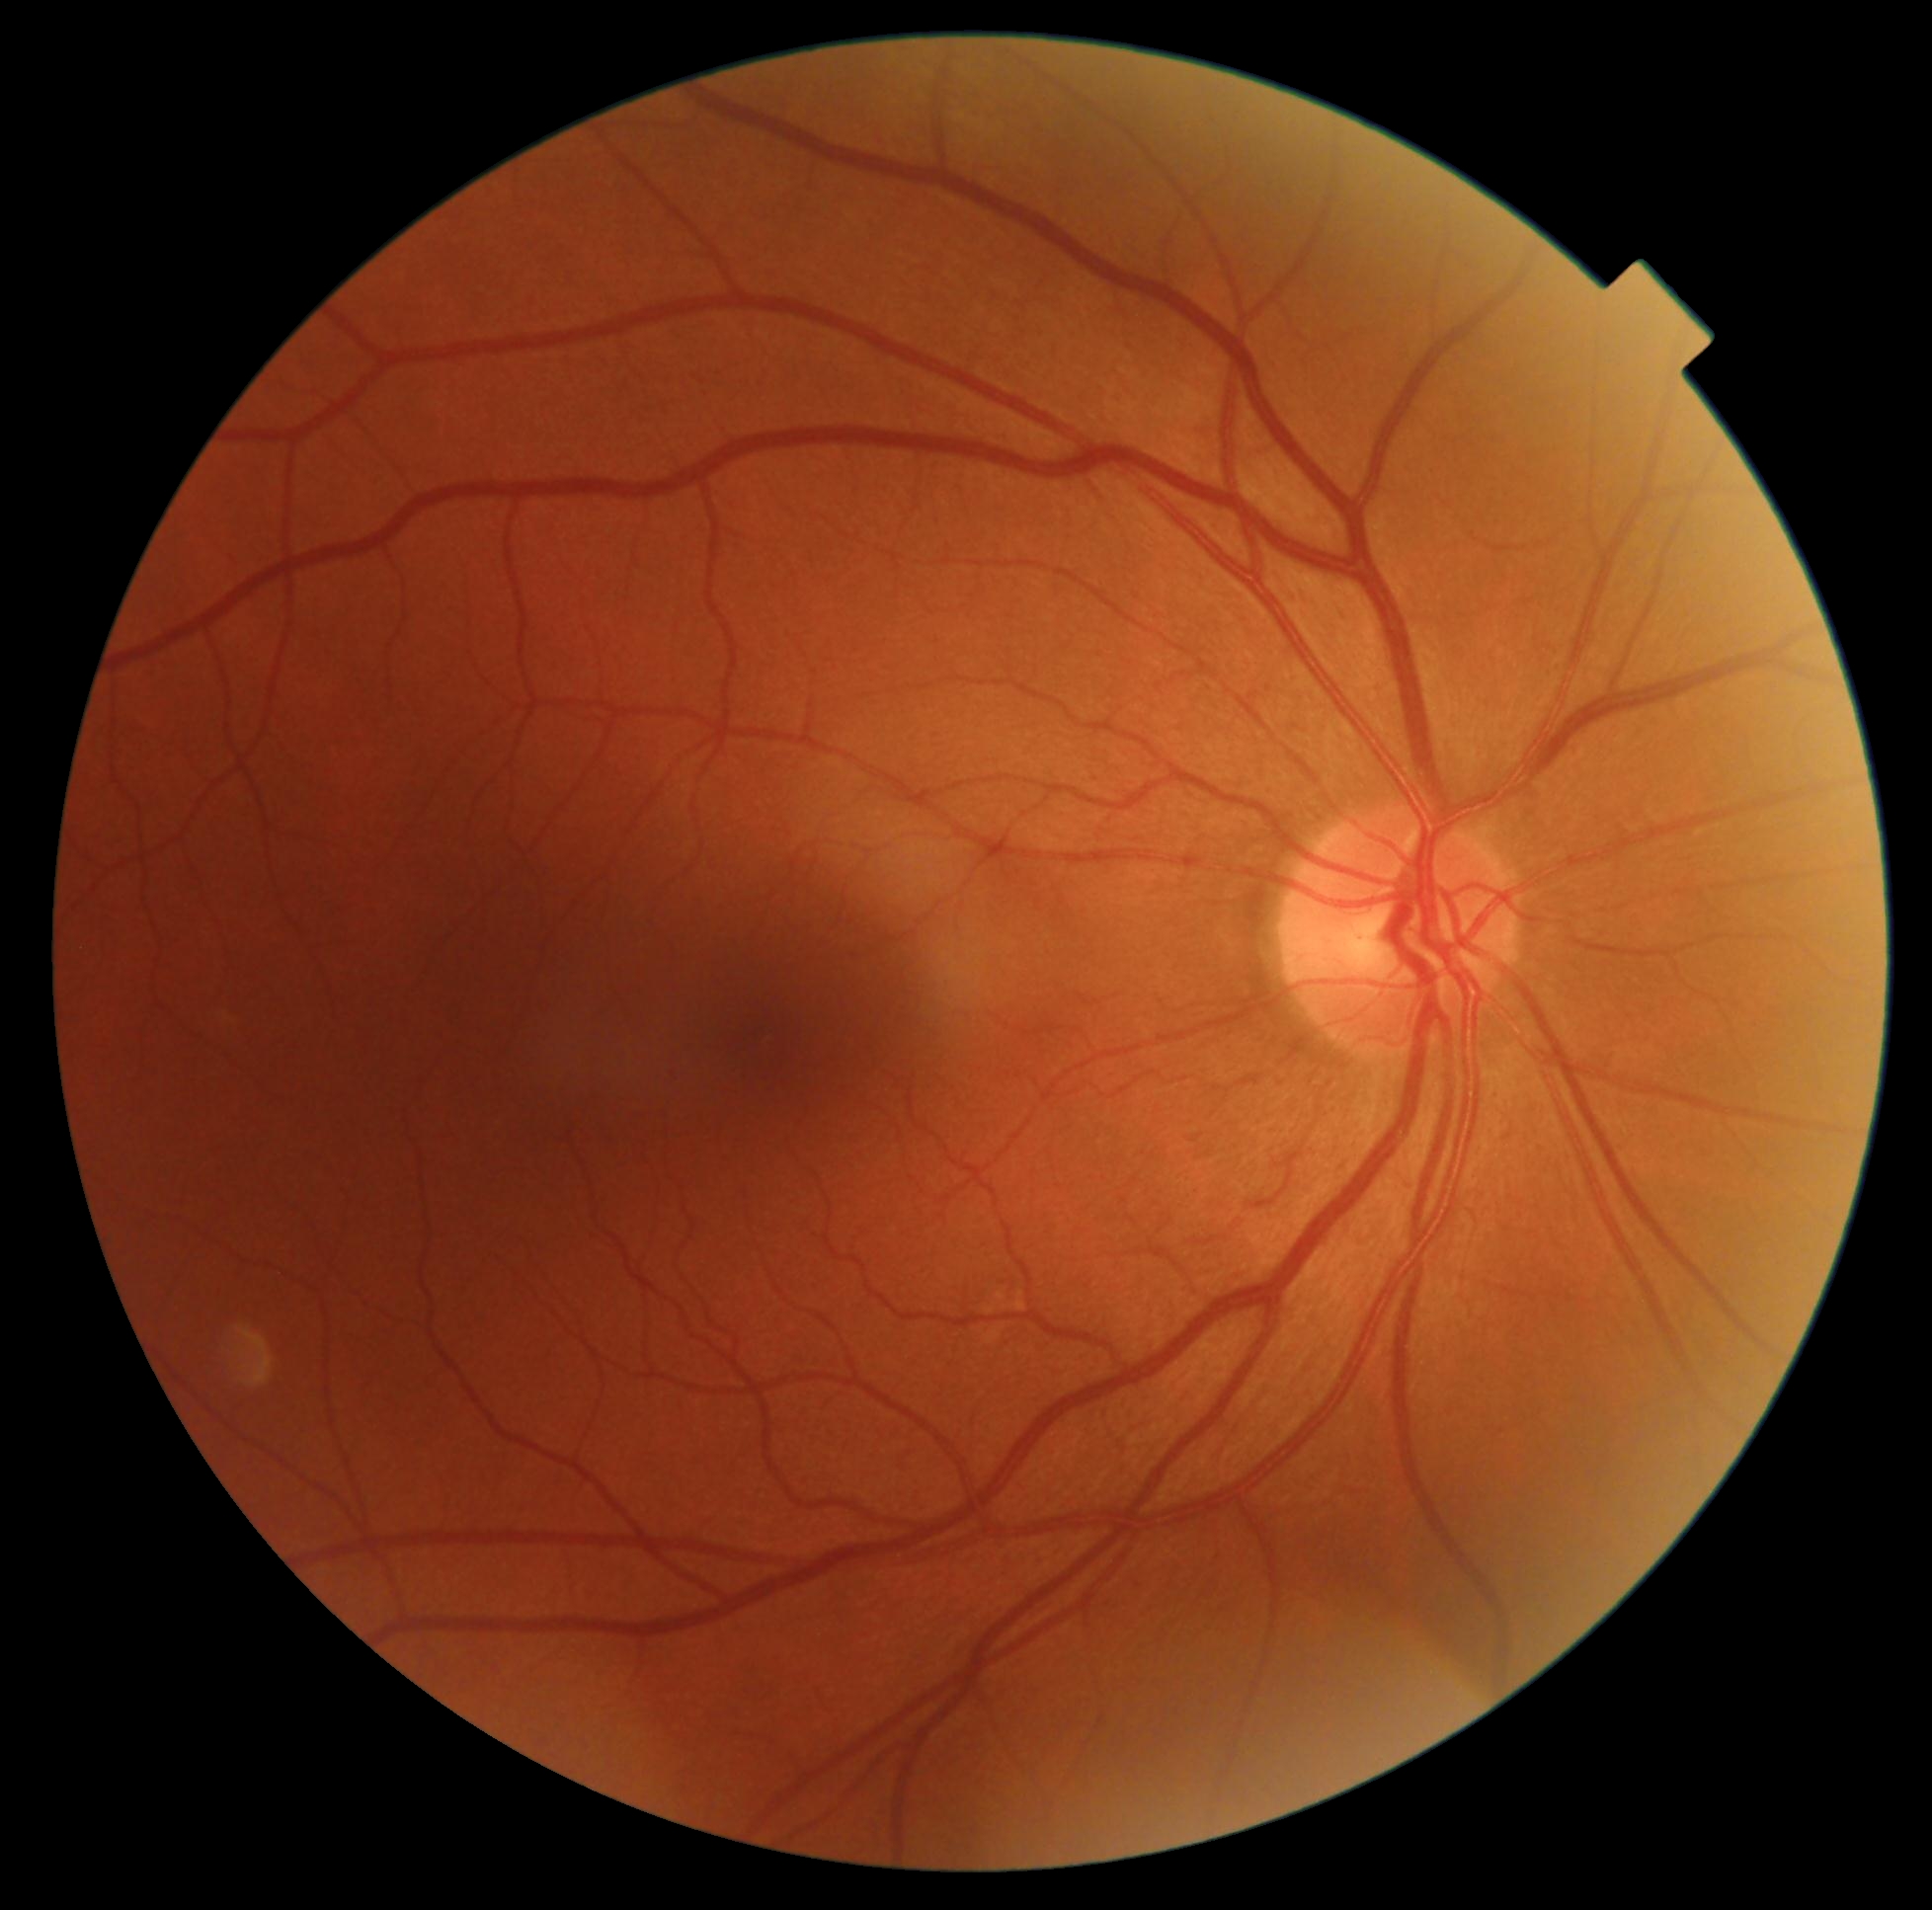
No signs of diabetic retinopathy. Diabetic retinopathy severity is 0 — no visible signs of diabetic retinopathy.